Image size 1240x1240; wide-field fundus image from infant ROP screening
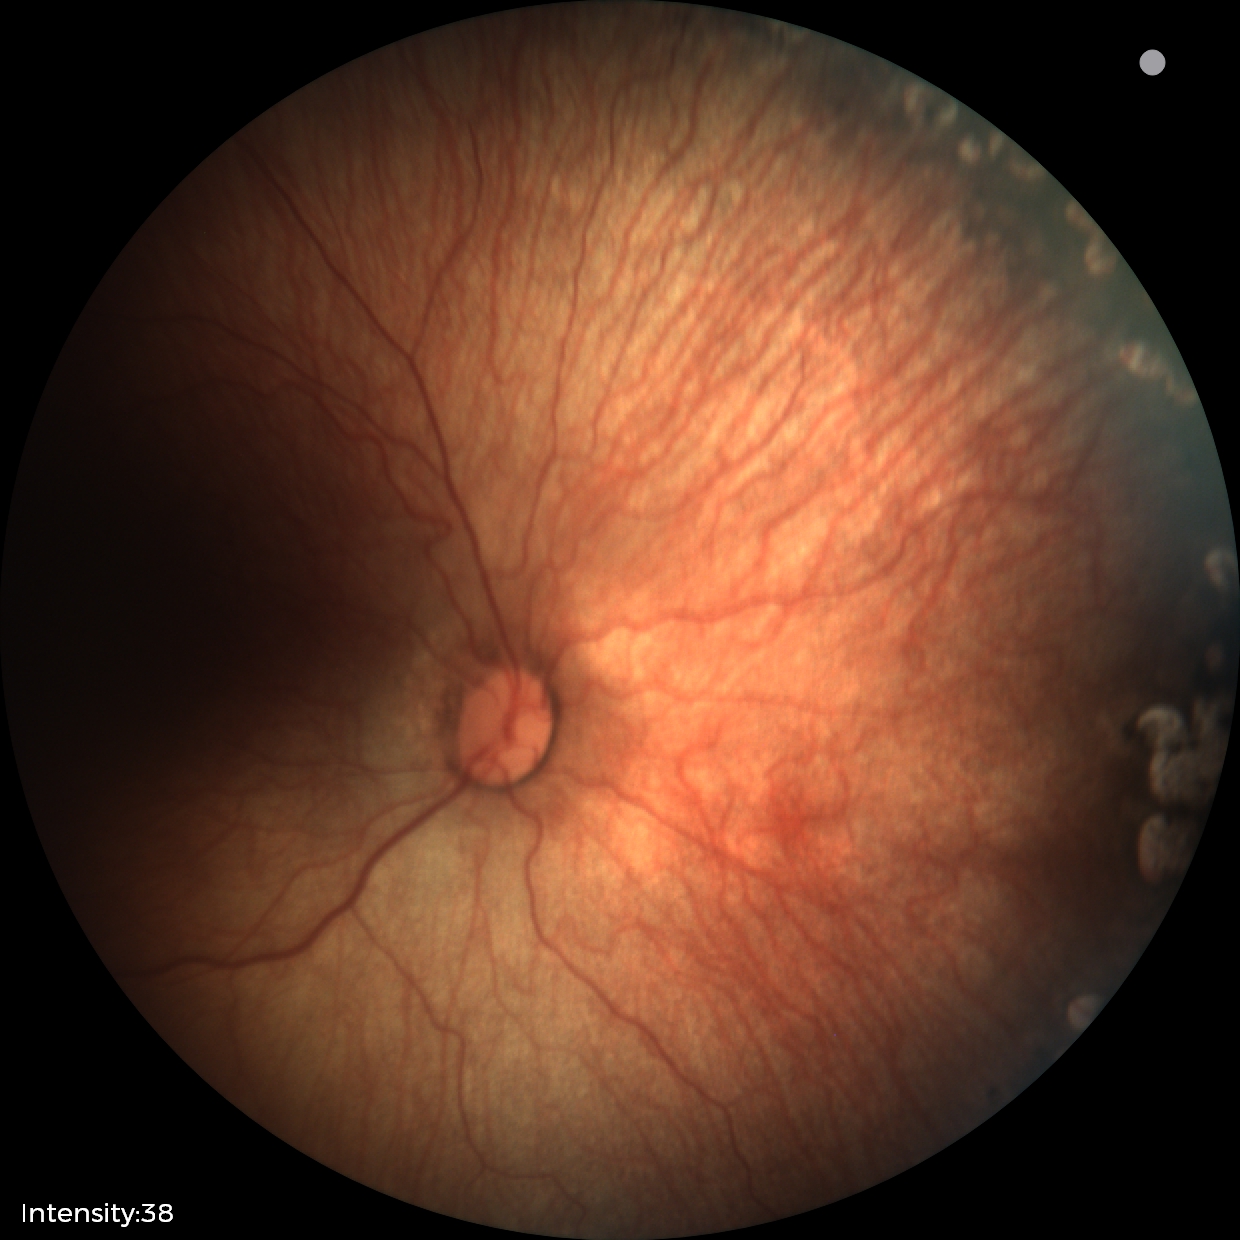
Diagnosis: status post retinopathy of prematurity.